Acquired with a NIDEK AFC-230:
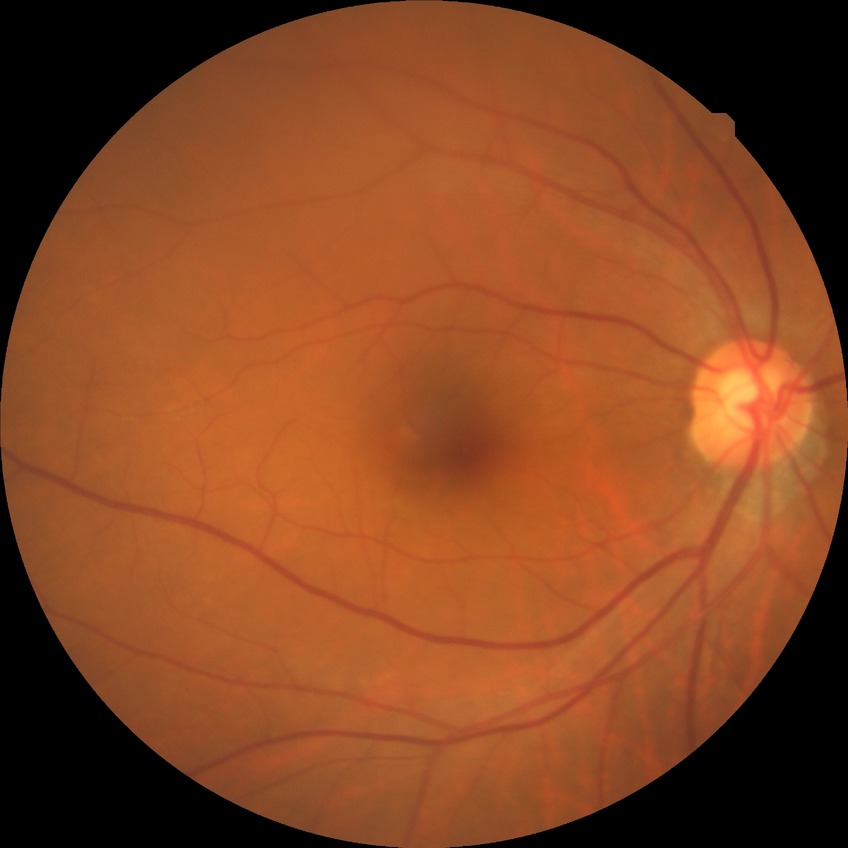 diabetic retinopathy (DR)=no diabetic retinopathy (NDR).